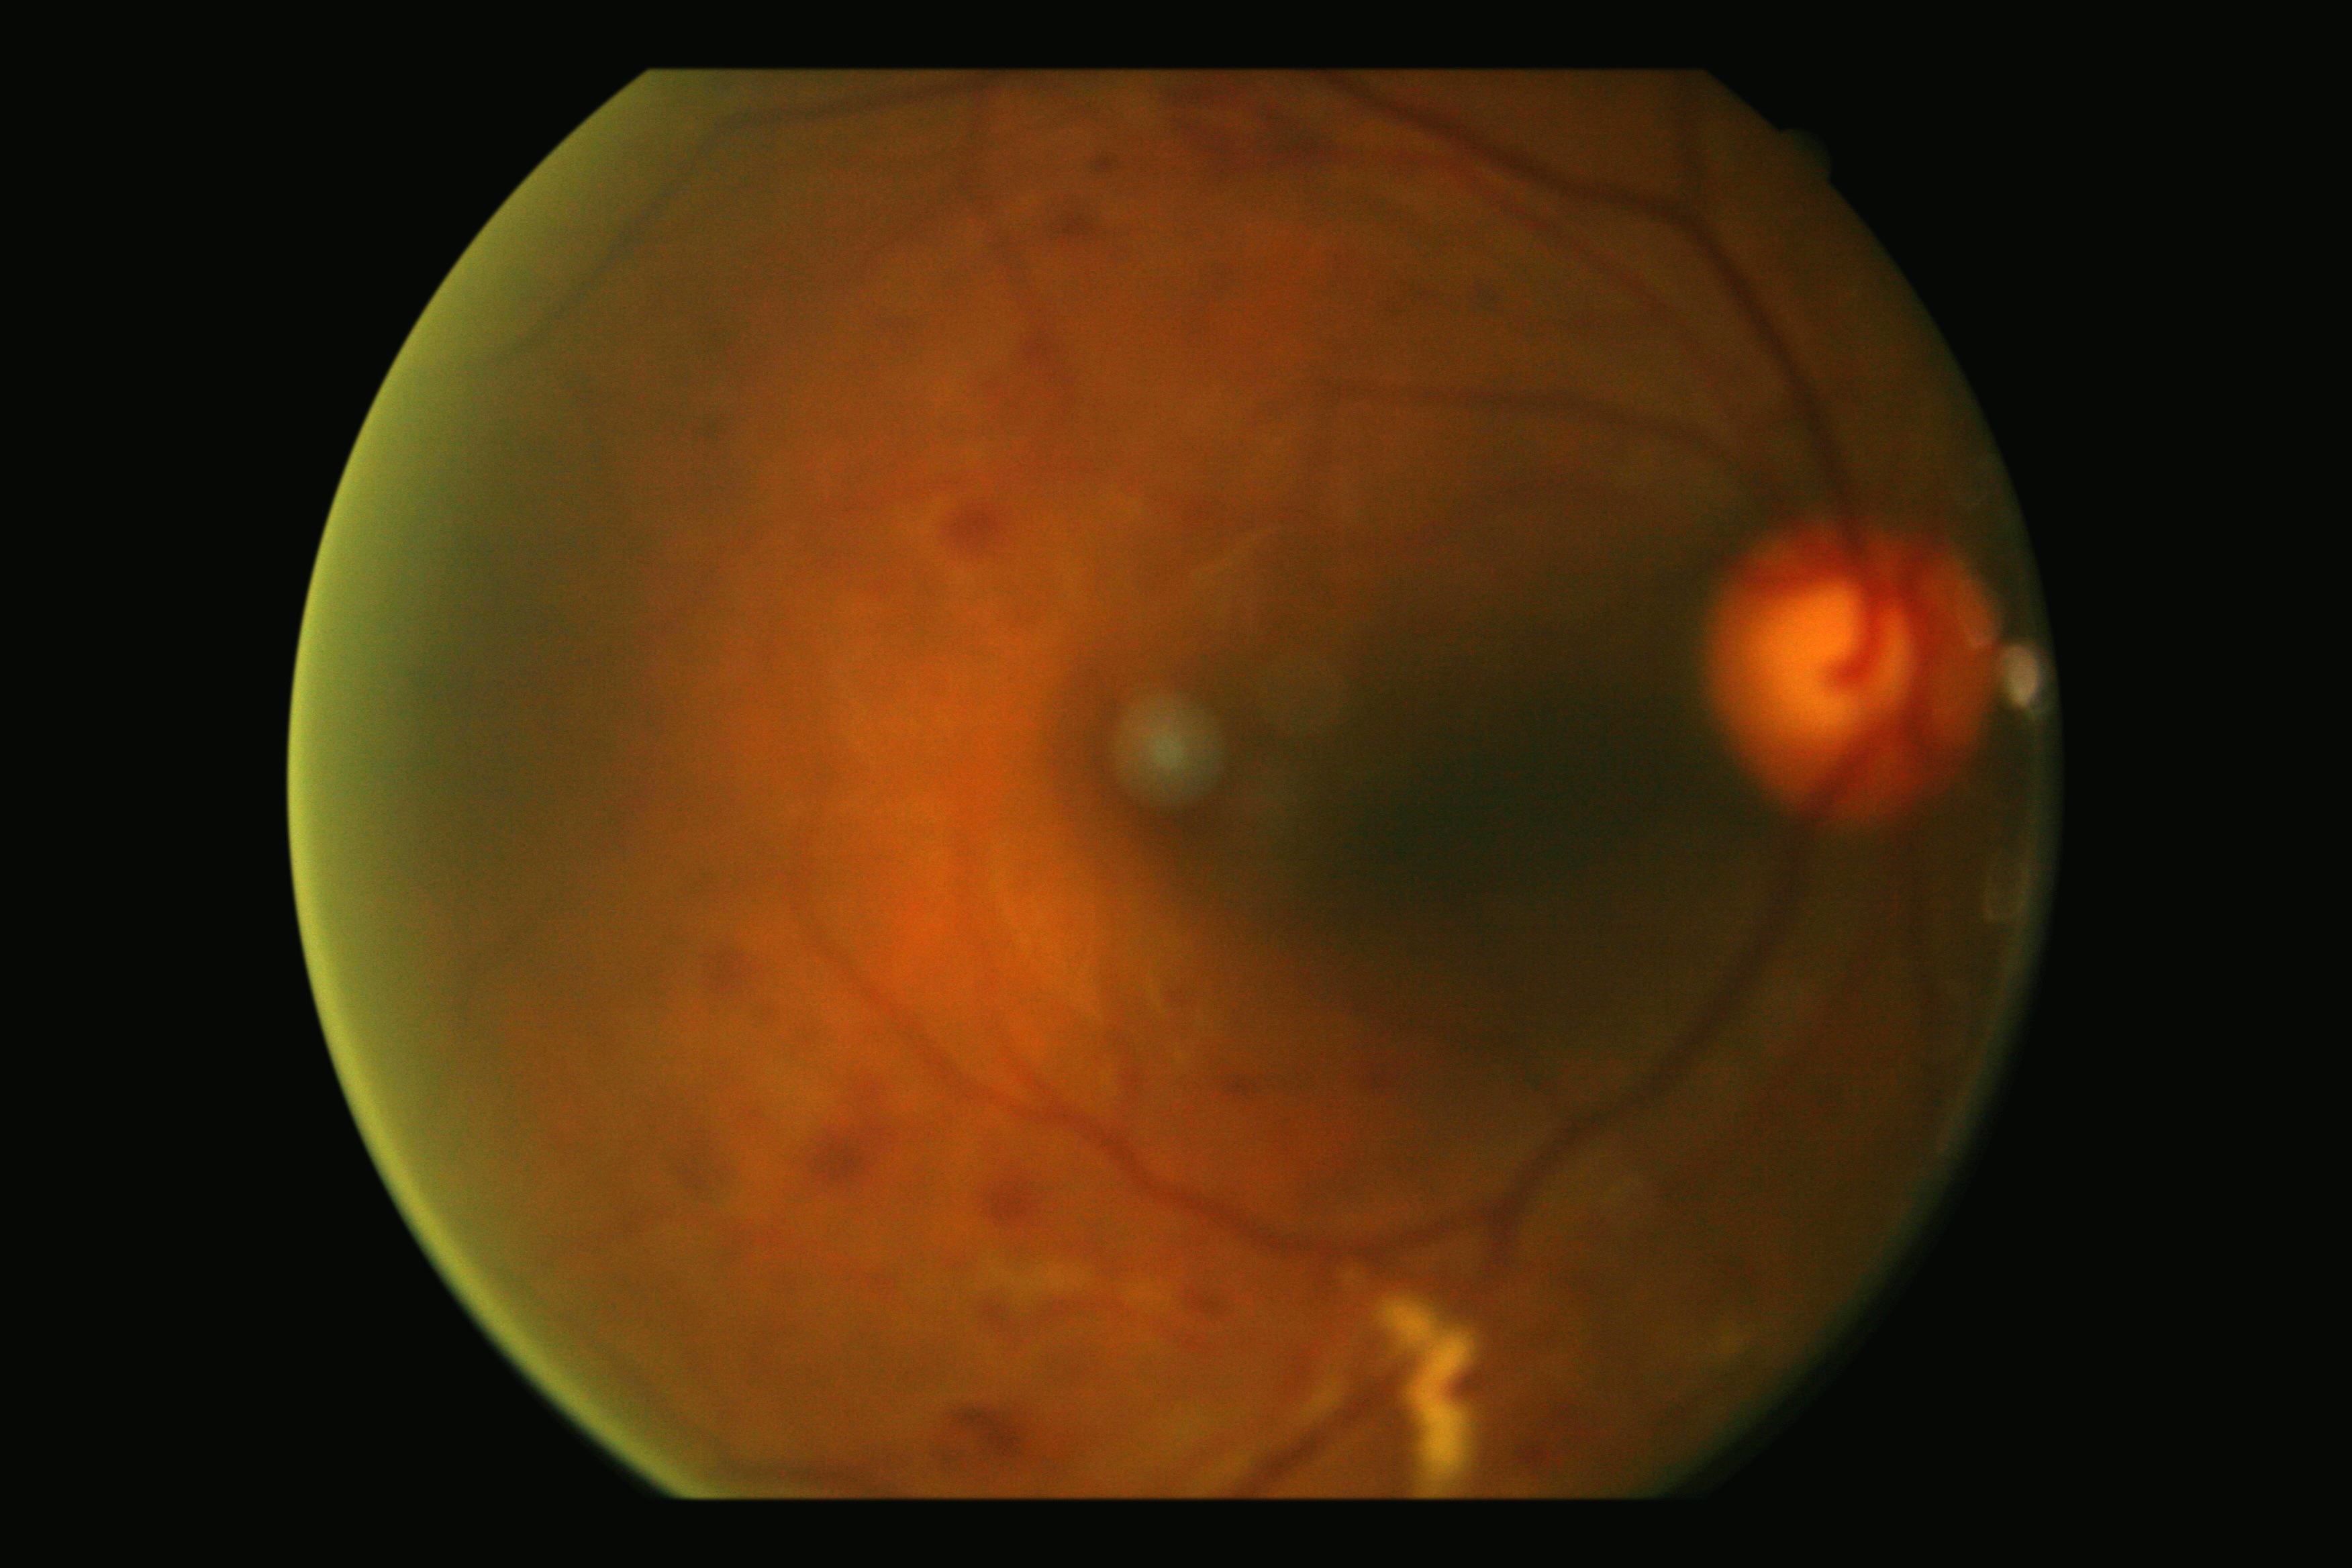
• diabetic retinopathy — grade 2 (moderate NPDR)